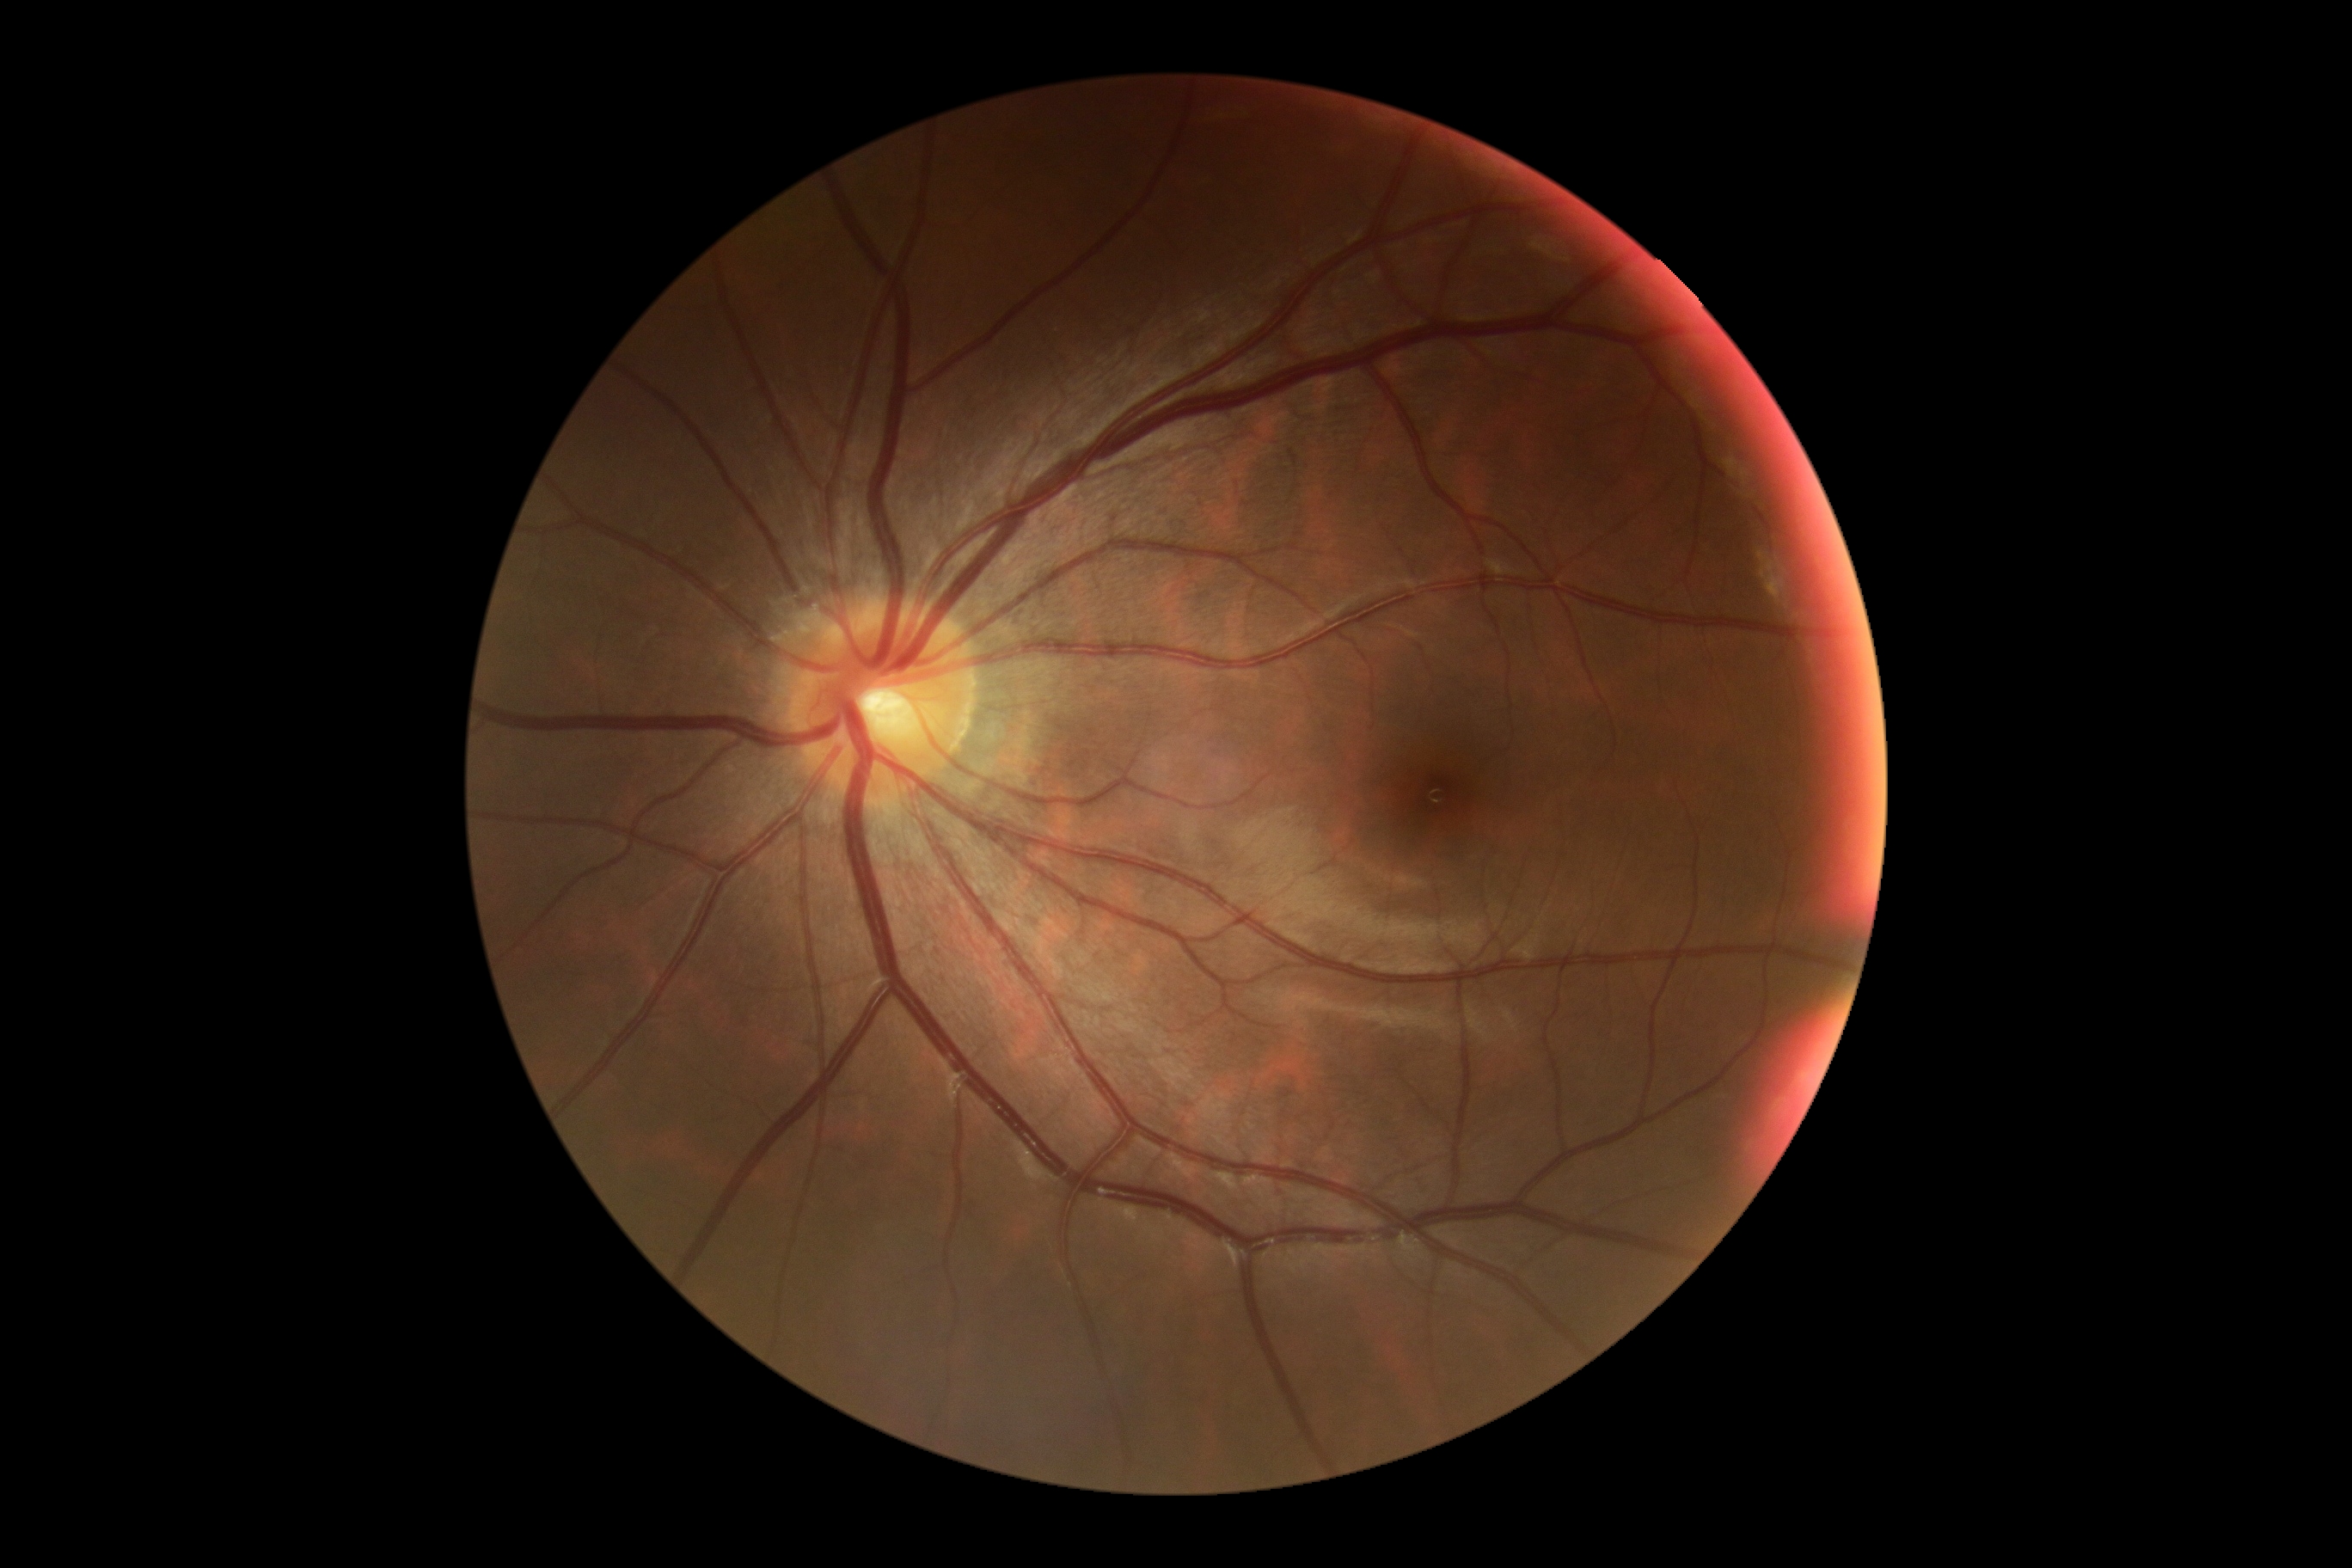 Findings:
– DR grade — 0/4